Optic disc region crop.
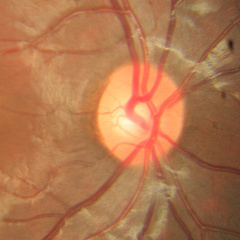
No glaucomatous optic neuropathy.